Image size 2352x1568 · color fundus photograph
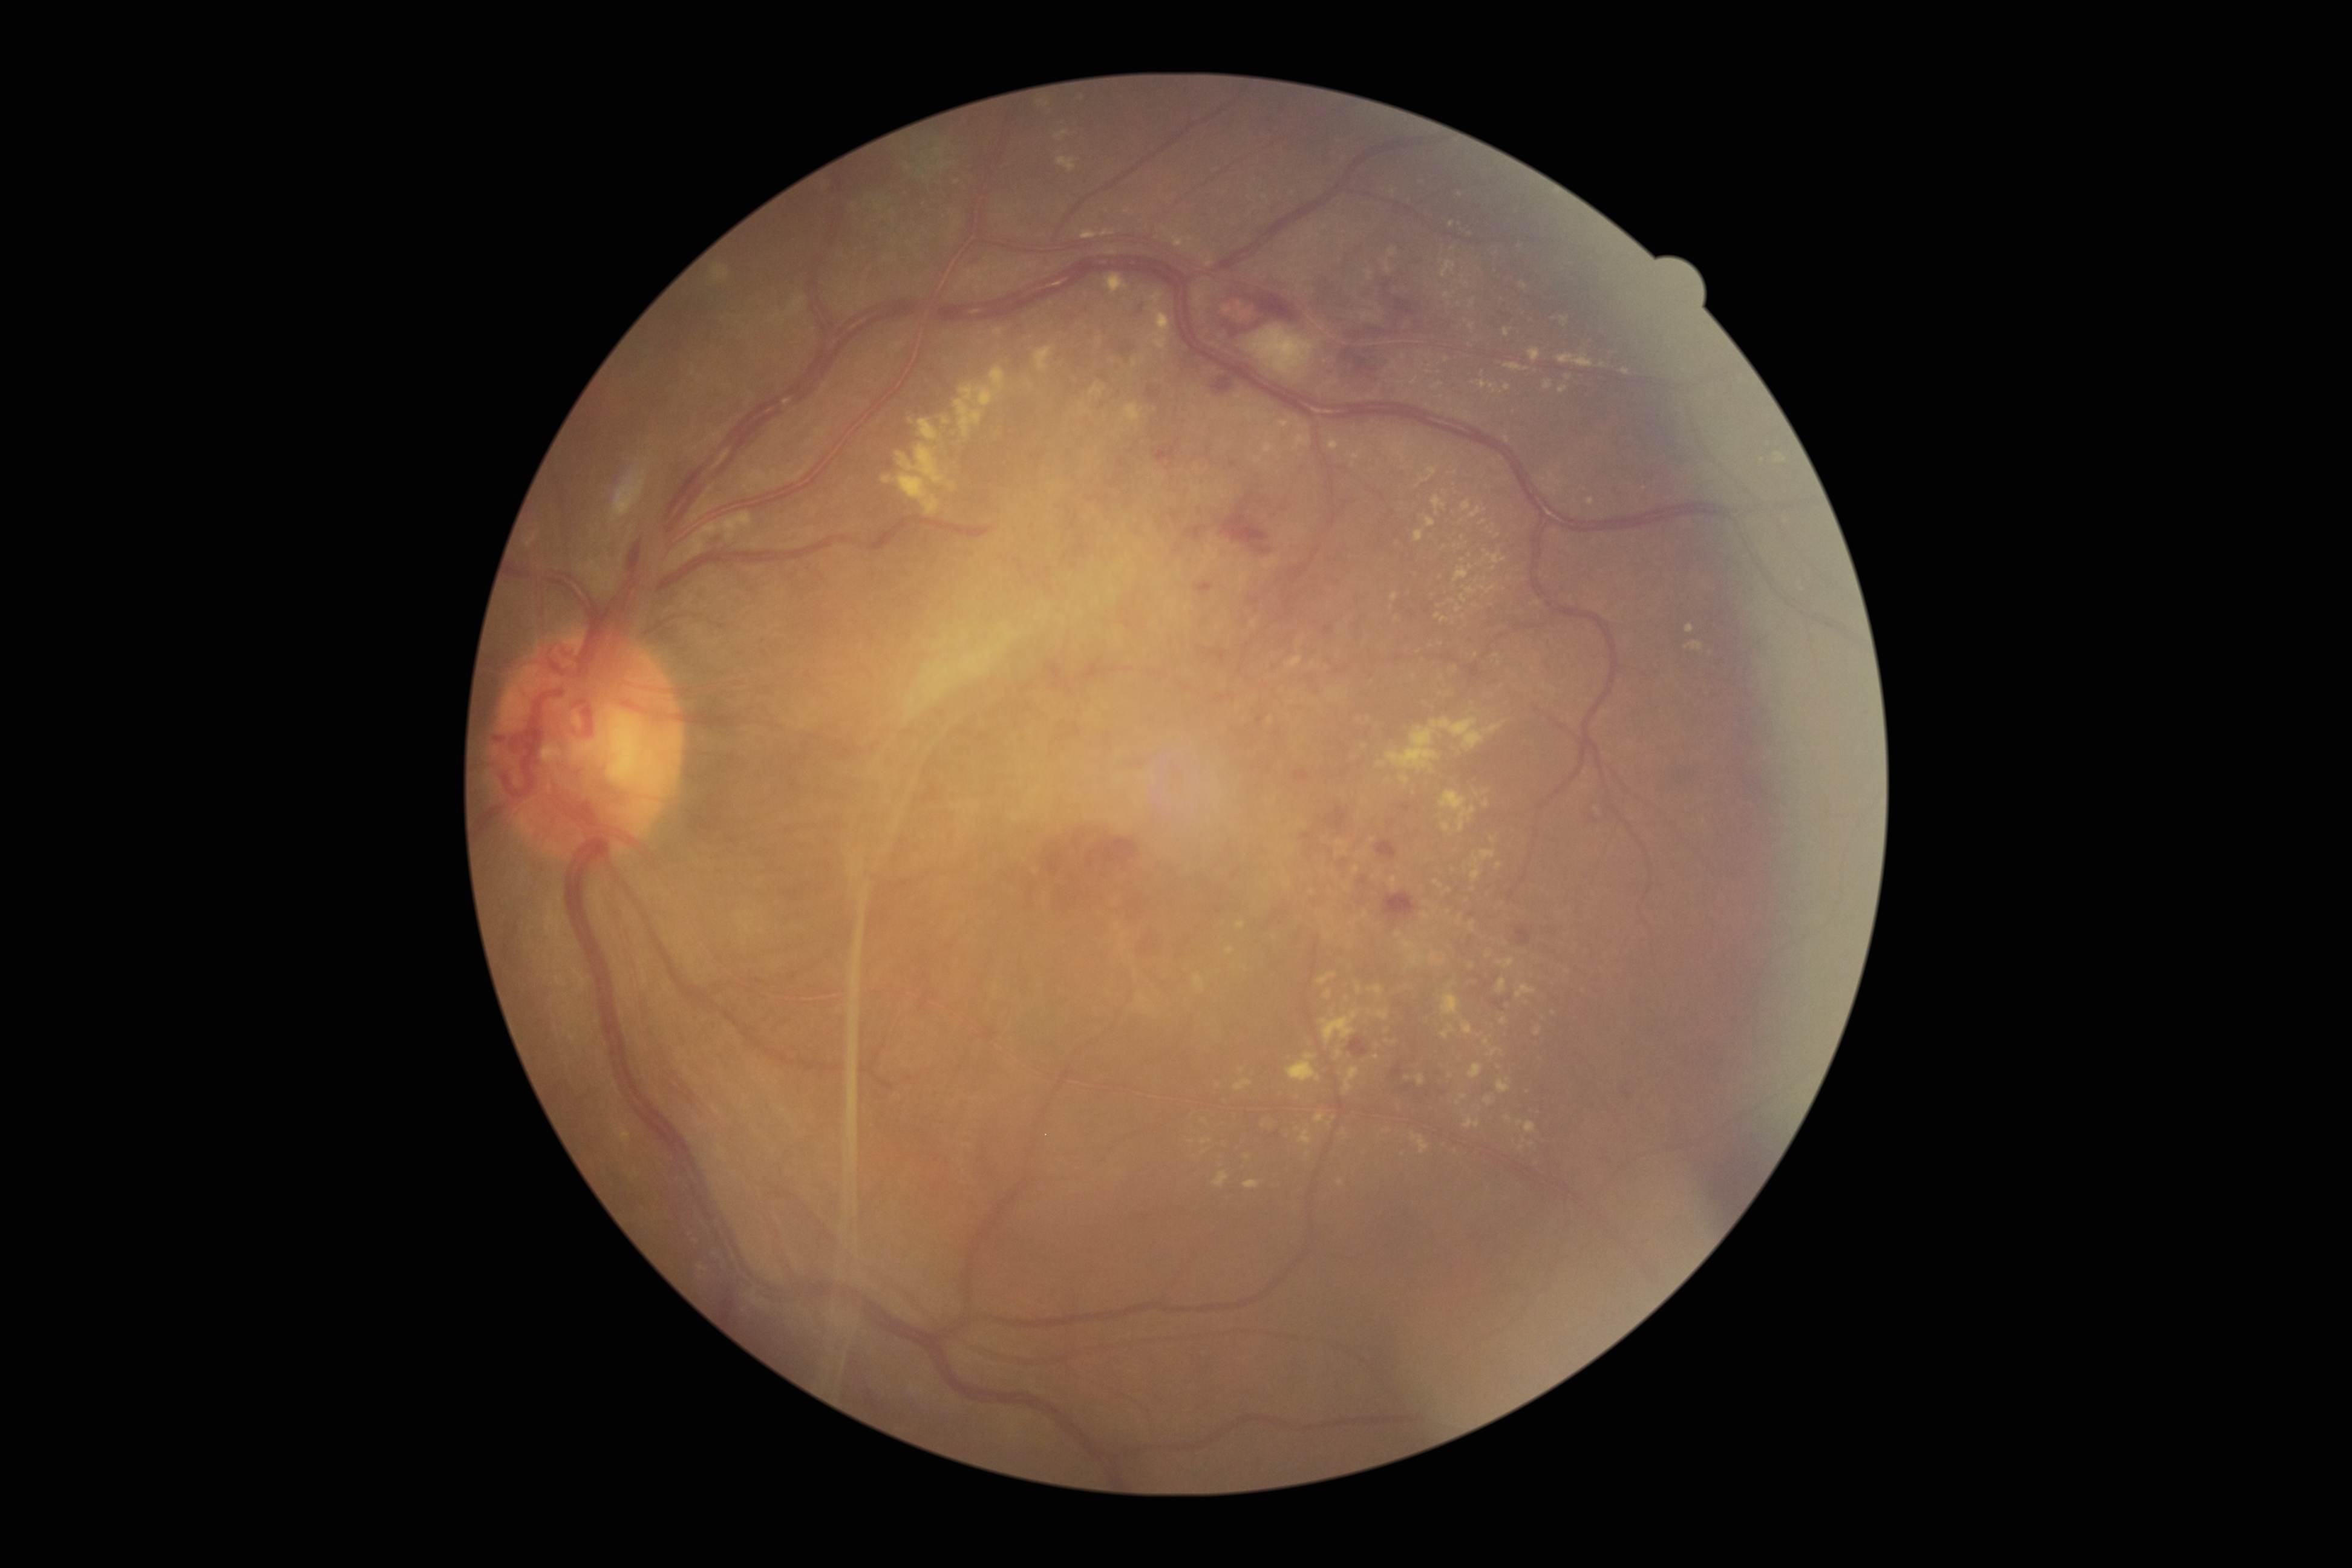
partial: true
dr_grade: 4
lesions:
  ex:
    - x1=1410 y1=952 x2=1425 y2=965
    - x1=1293 y1=434 x2=1311 y2=452
    - x1=1144 y1=1007 x2=1154 y2=1013
    - x1=918 y1=418 x2=939 y2=441
    - x1=1560 y1=316 x2=1569 y2=322
    - x1=1454 y1=567 x2=1468 y2=583
    - x1=1201 y1=1138 x2=1212 y2=1145
    - x1=1390 y1=877 x2=1397 y2=890
    - x1=1443 y1=289 x2=1460 y2=298
    - x1=1367 y1=270 x2=1374 y2=280
    - x1=1483 y1=800 x2=1489 y2=808
    - x1=1497 y1=978 x2=1506 y2=993
  ex_small_centers:
    - Point(1376, 1057)
    - Point(1553, 1013)
    - Point(1408, 1078)
    - Point(1441, 262)
    - Point(1482, 374)
    - Point(1521, 1147)
    - Point(1127, 212)
    - Point(1643, 489)